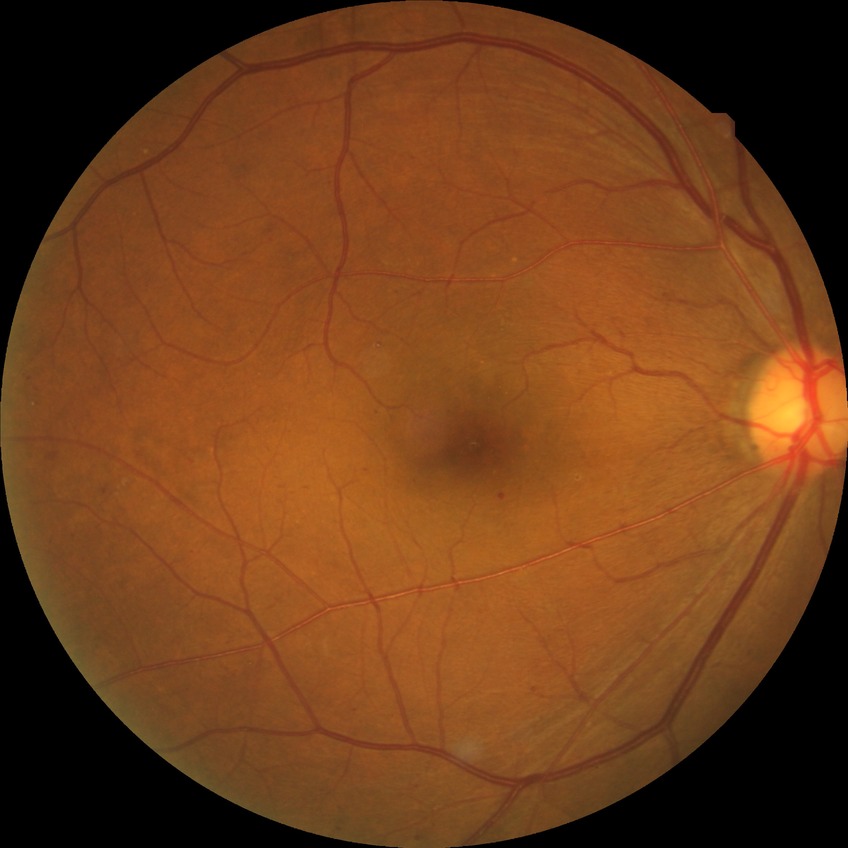

DR stage is SDR. DR class: non-proliferative diabetic retinopathy.